45° field of view. CFP:
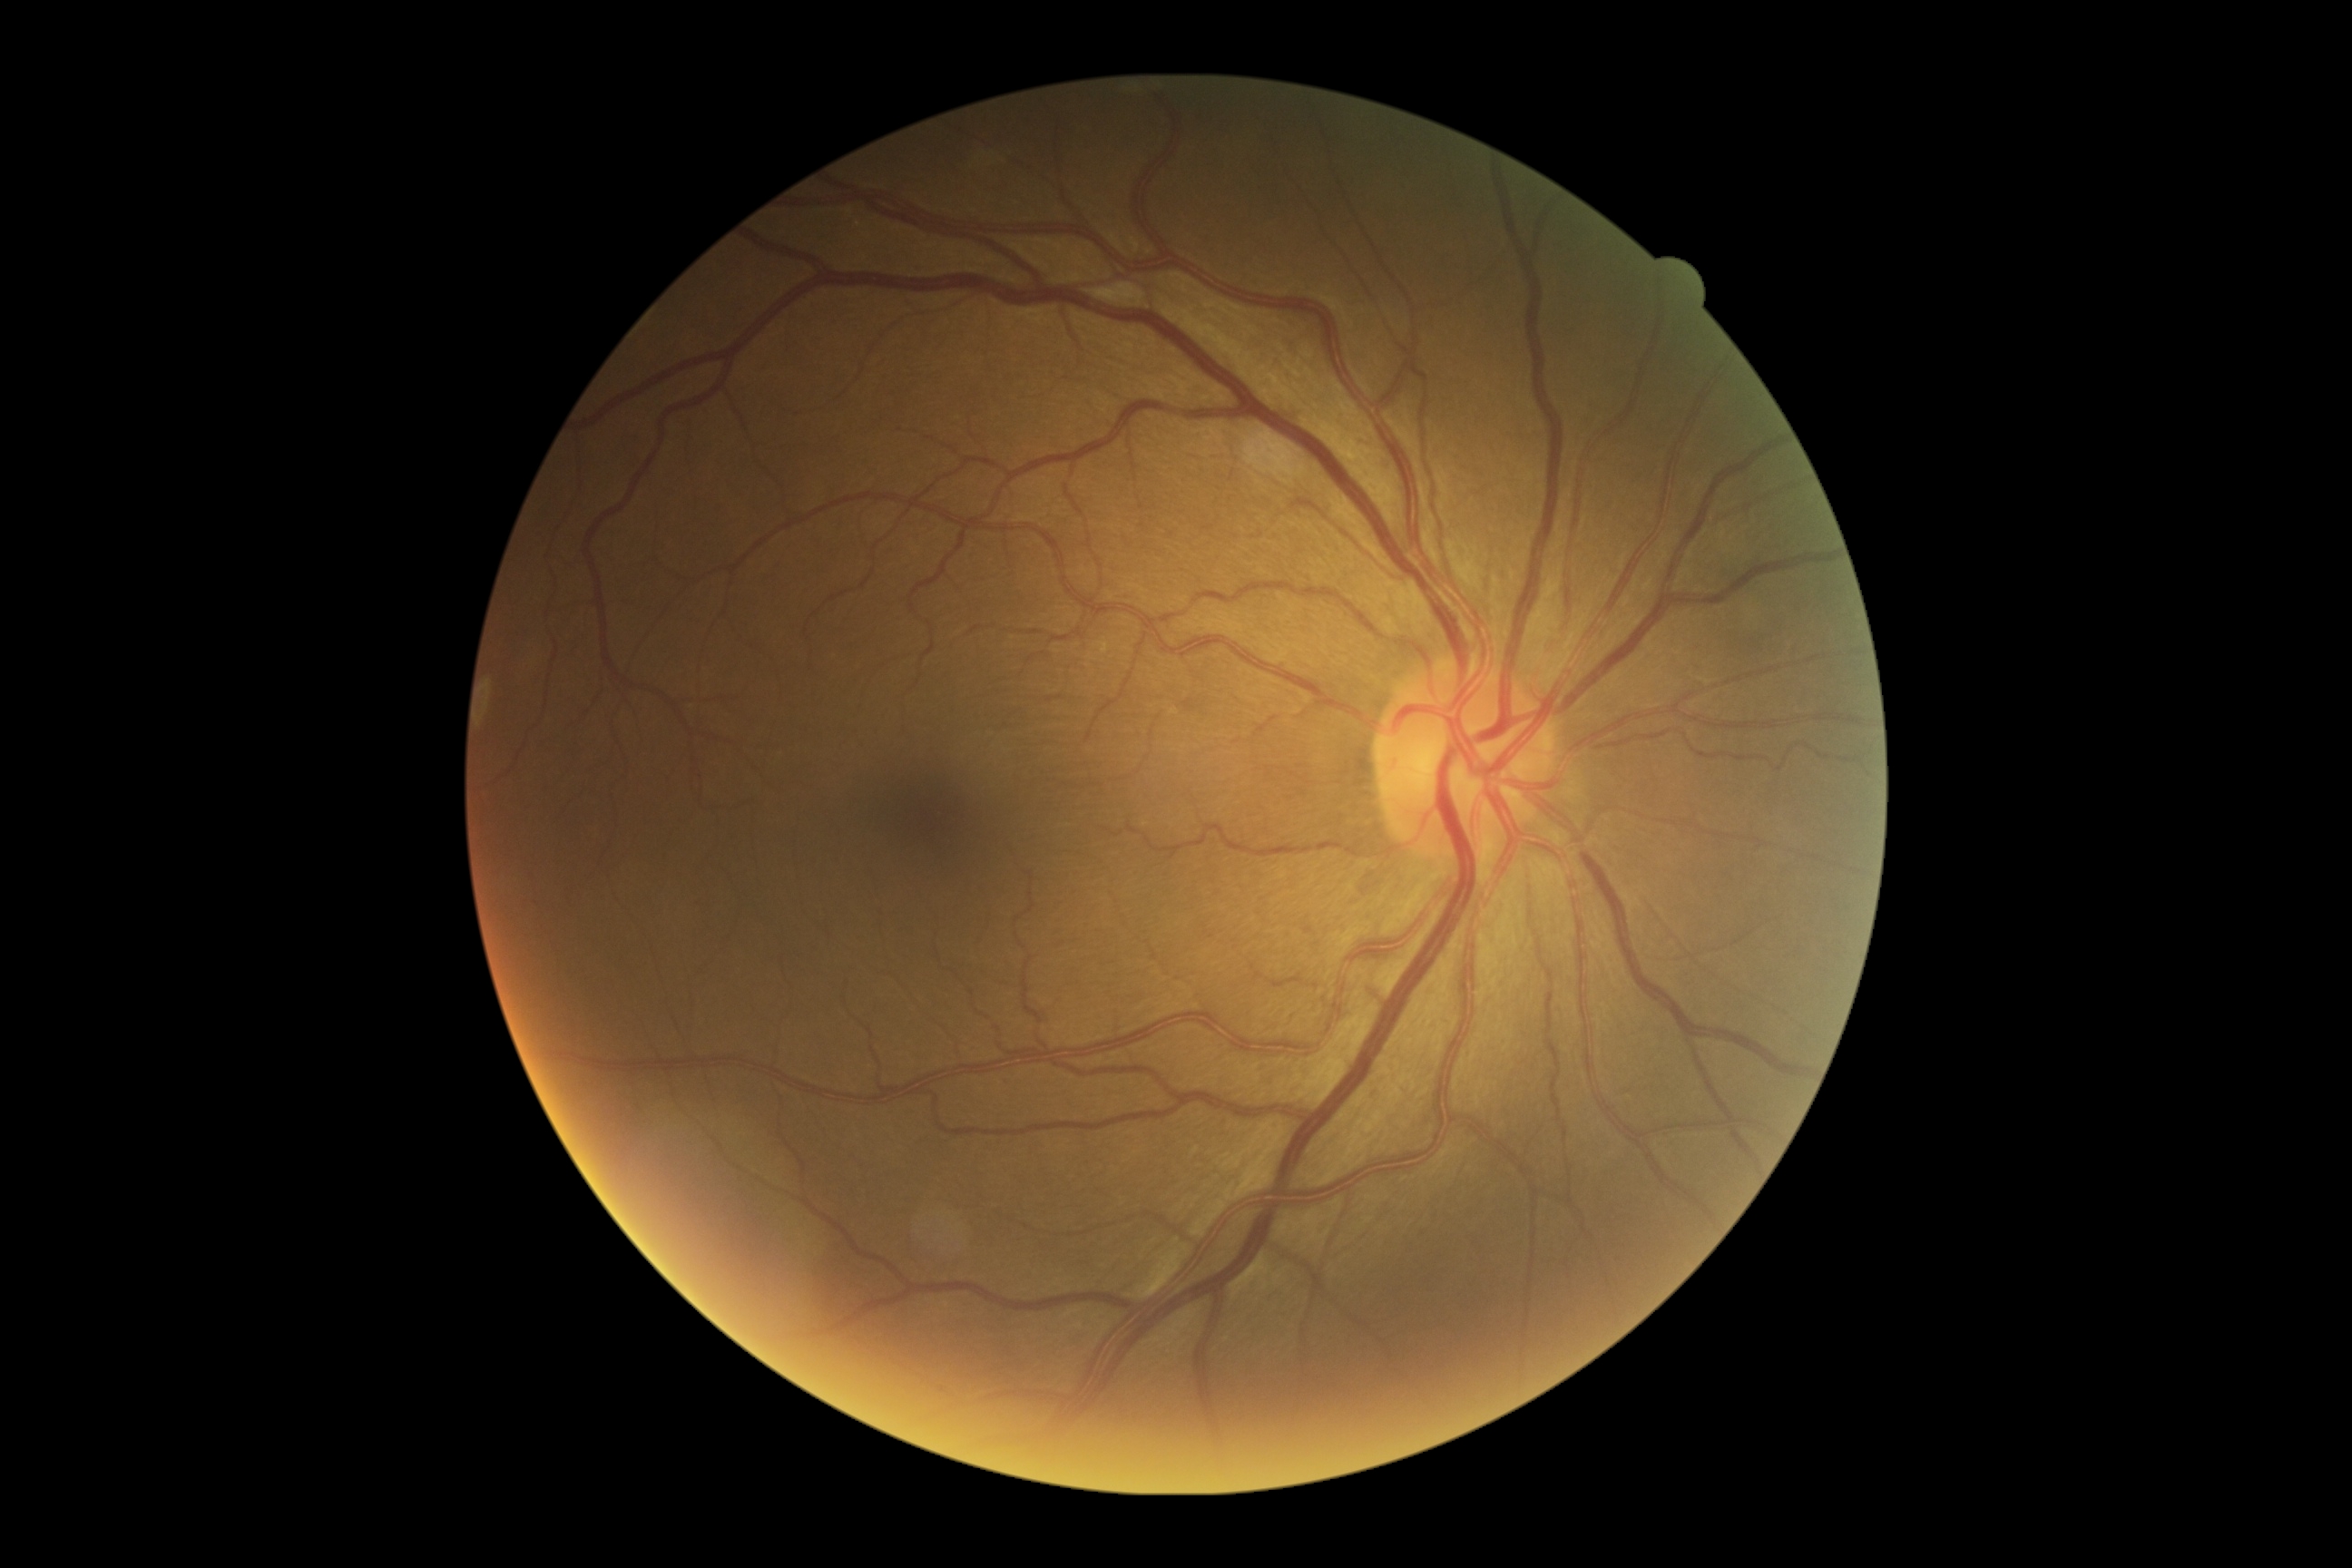 Annotations:
- diabetic retinopathy severity: grade 0 (no apparent retinopathy) — no visible signs of diabetic retinopathy